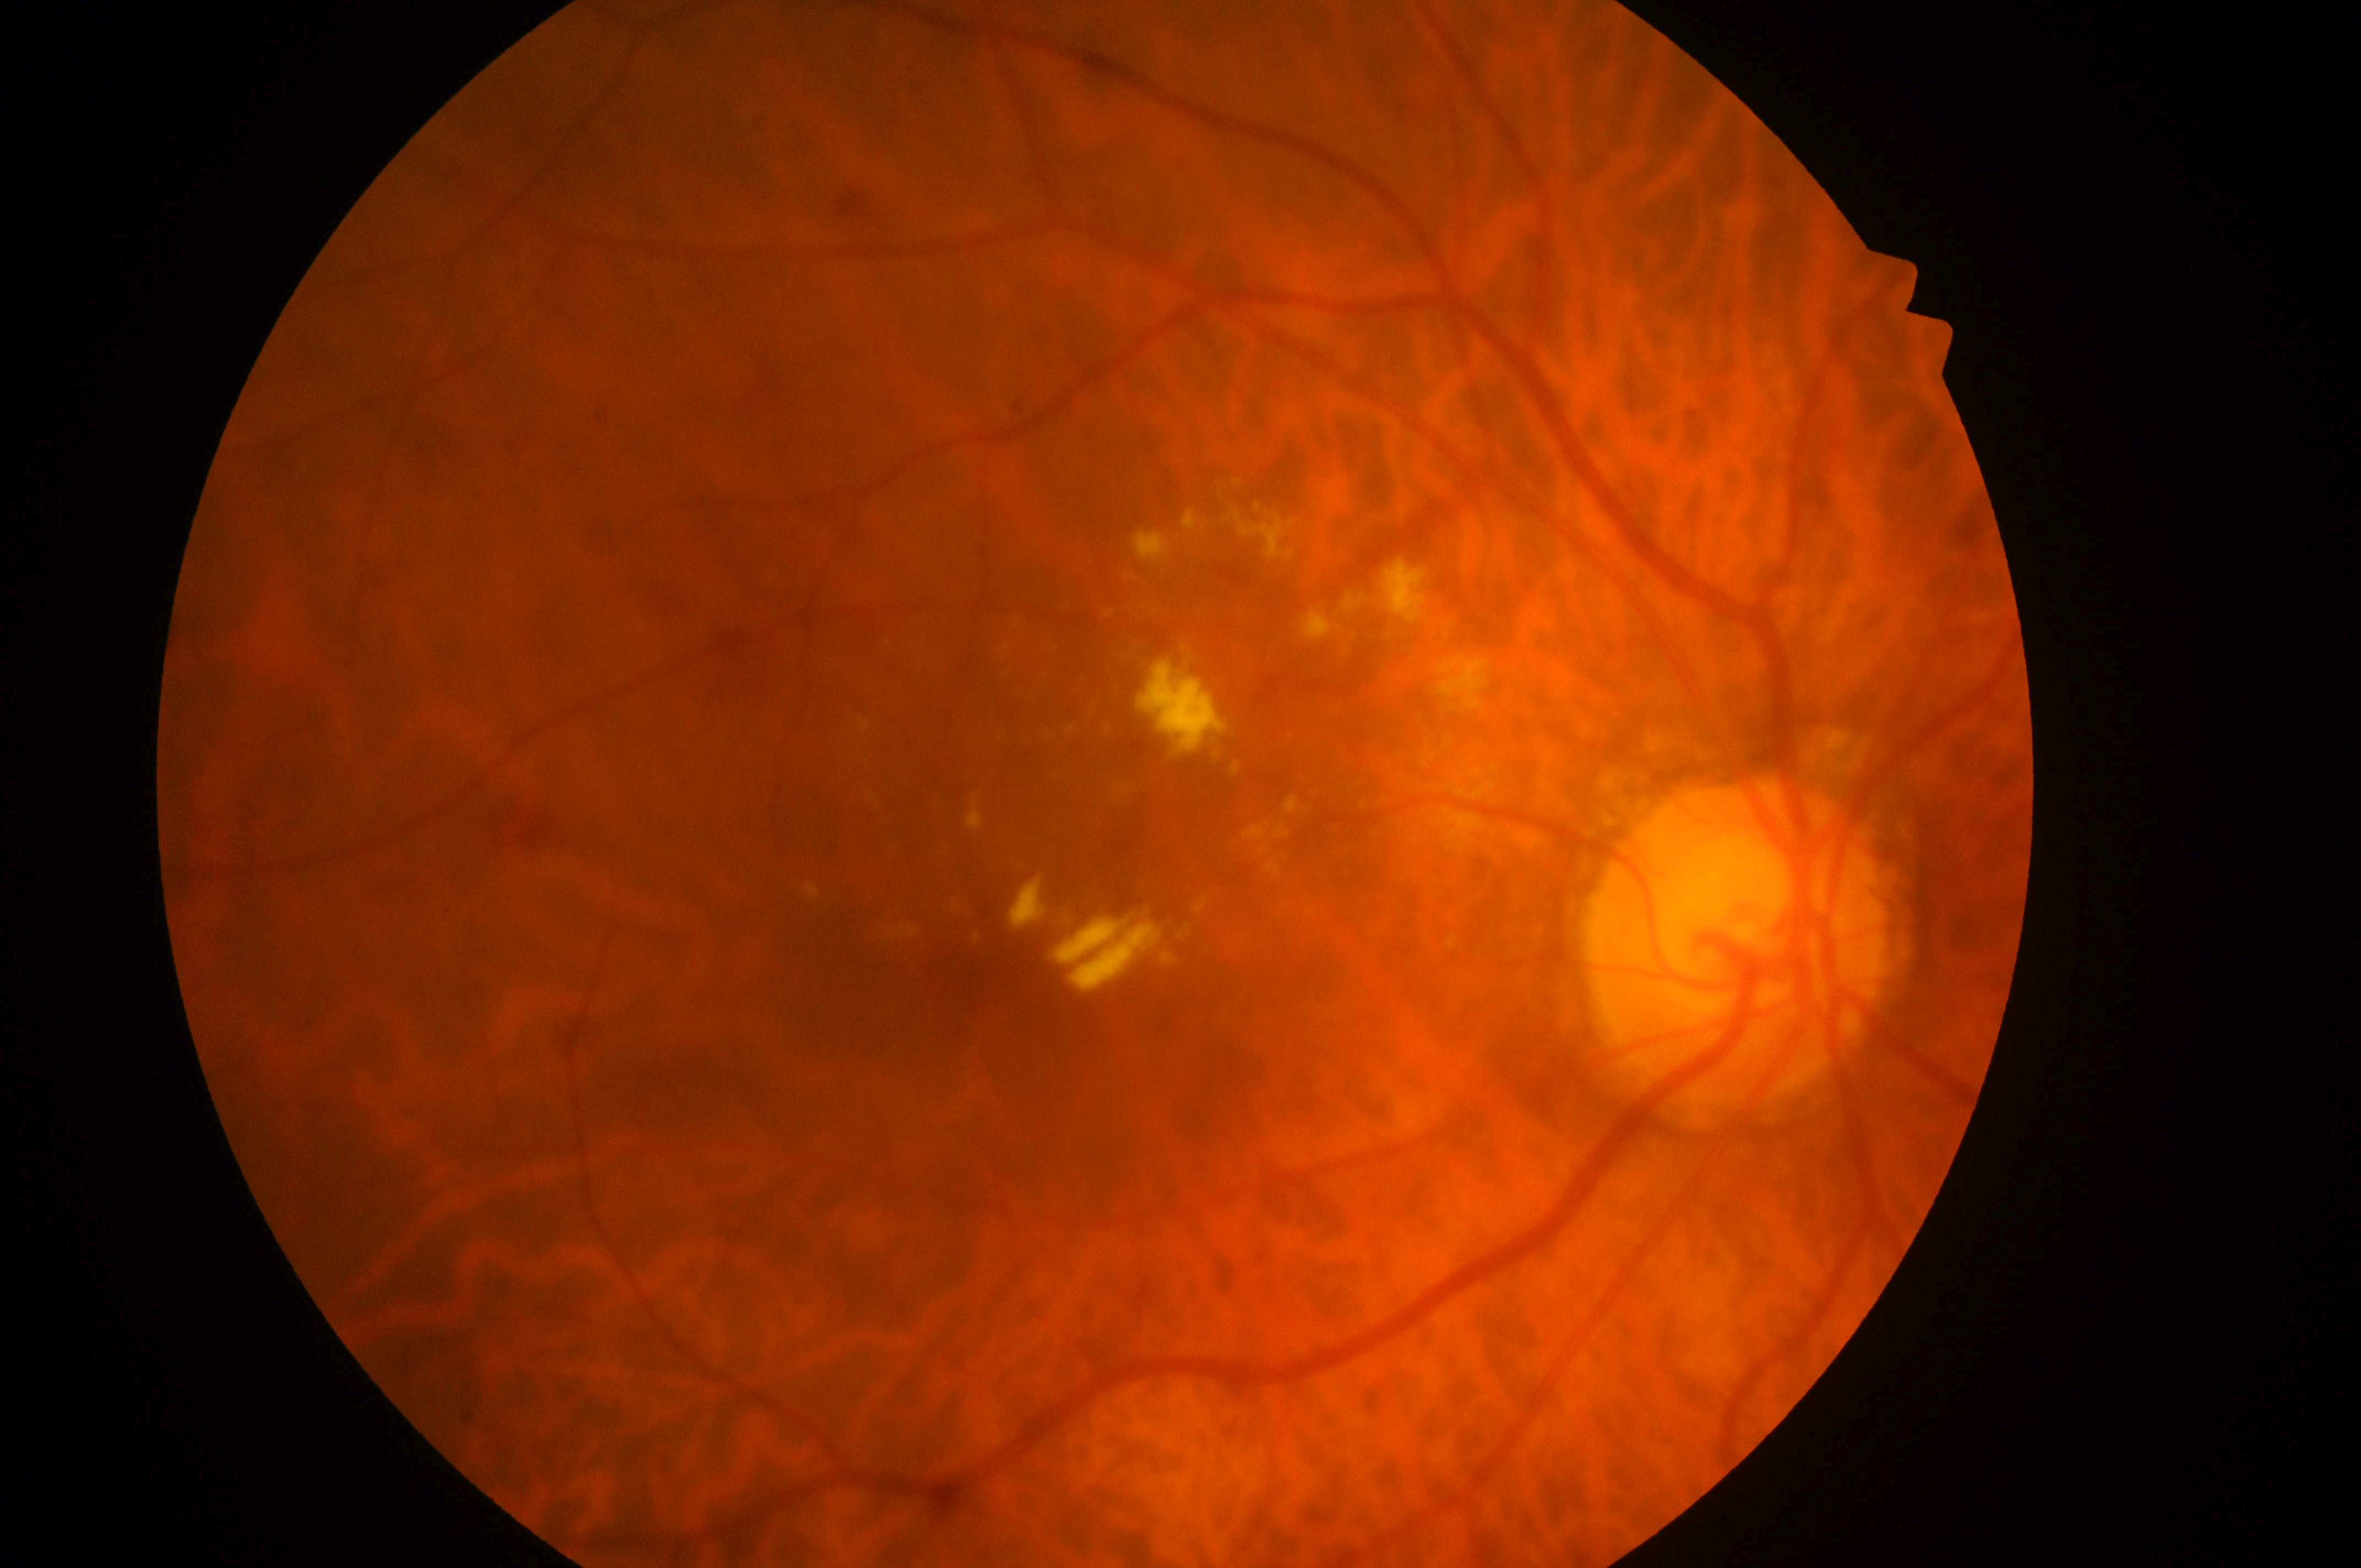
DR stage=moderate non-proliferative diabetic retinopathy (grade 2); optic disk=1735, 959; DME=high risk (grade 2); fovea=1013, 986; right eye.